NIDEK AFC-230
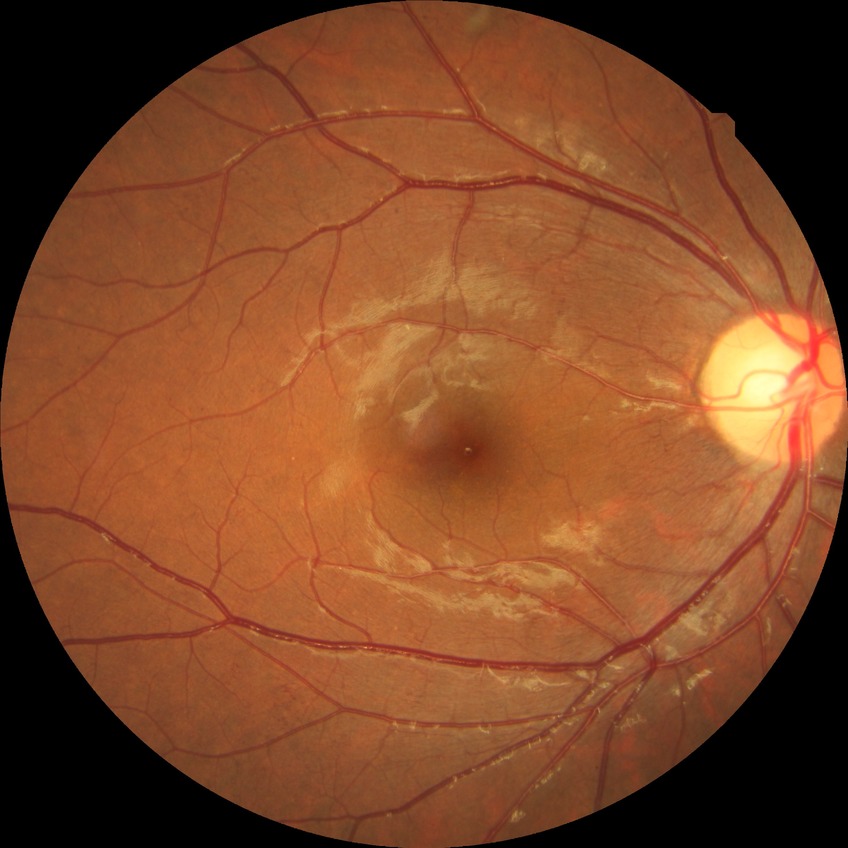
Disease class: non-proliferative diabetic retinopathy. DR is SDR.